DR severity per modified Davis staging: 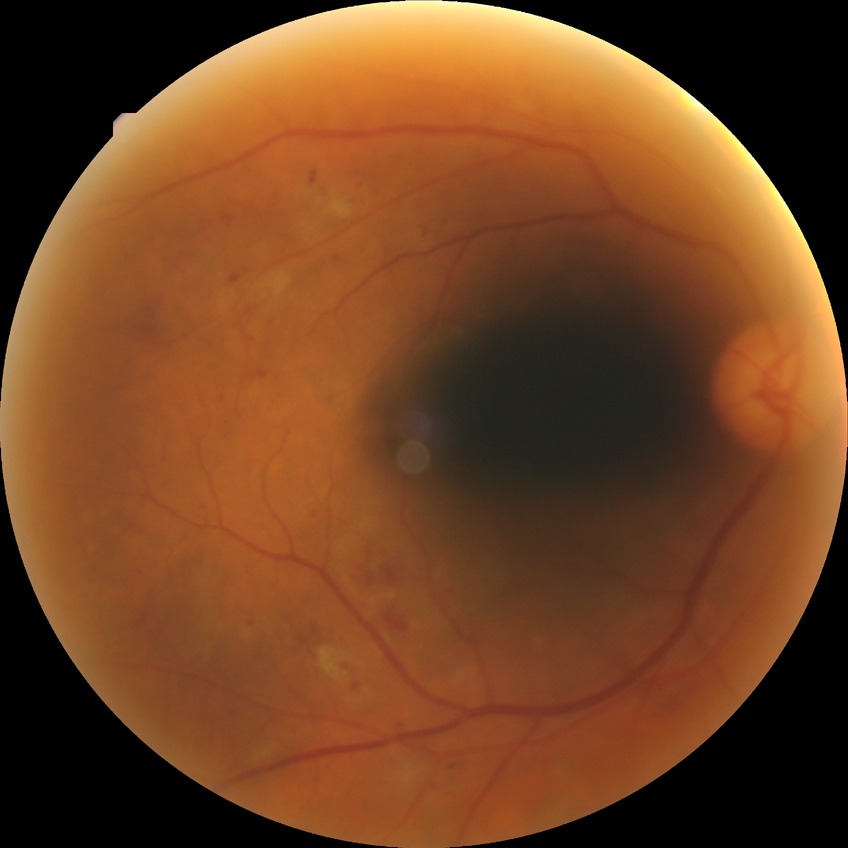
Diabetic retinopathy (DR): no diabetic retinopathy (NDR).